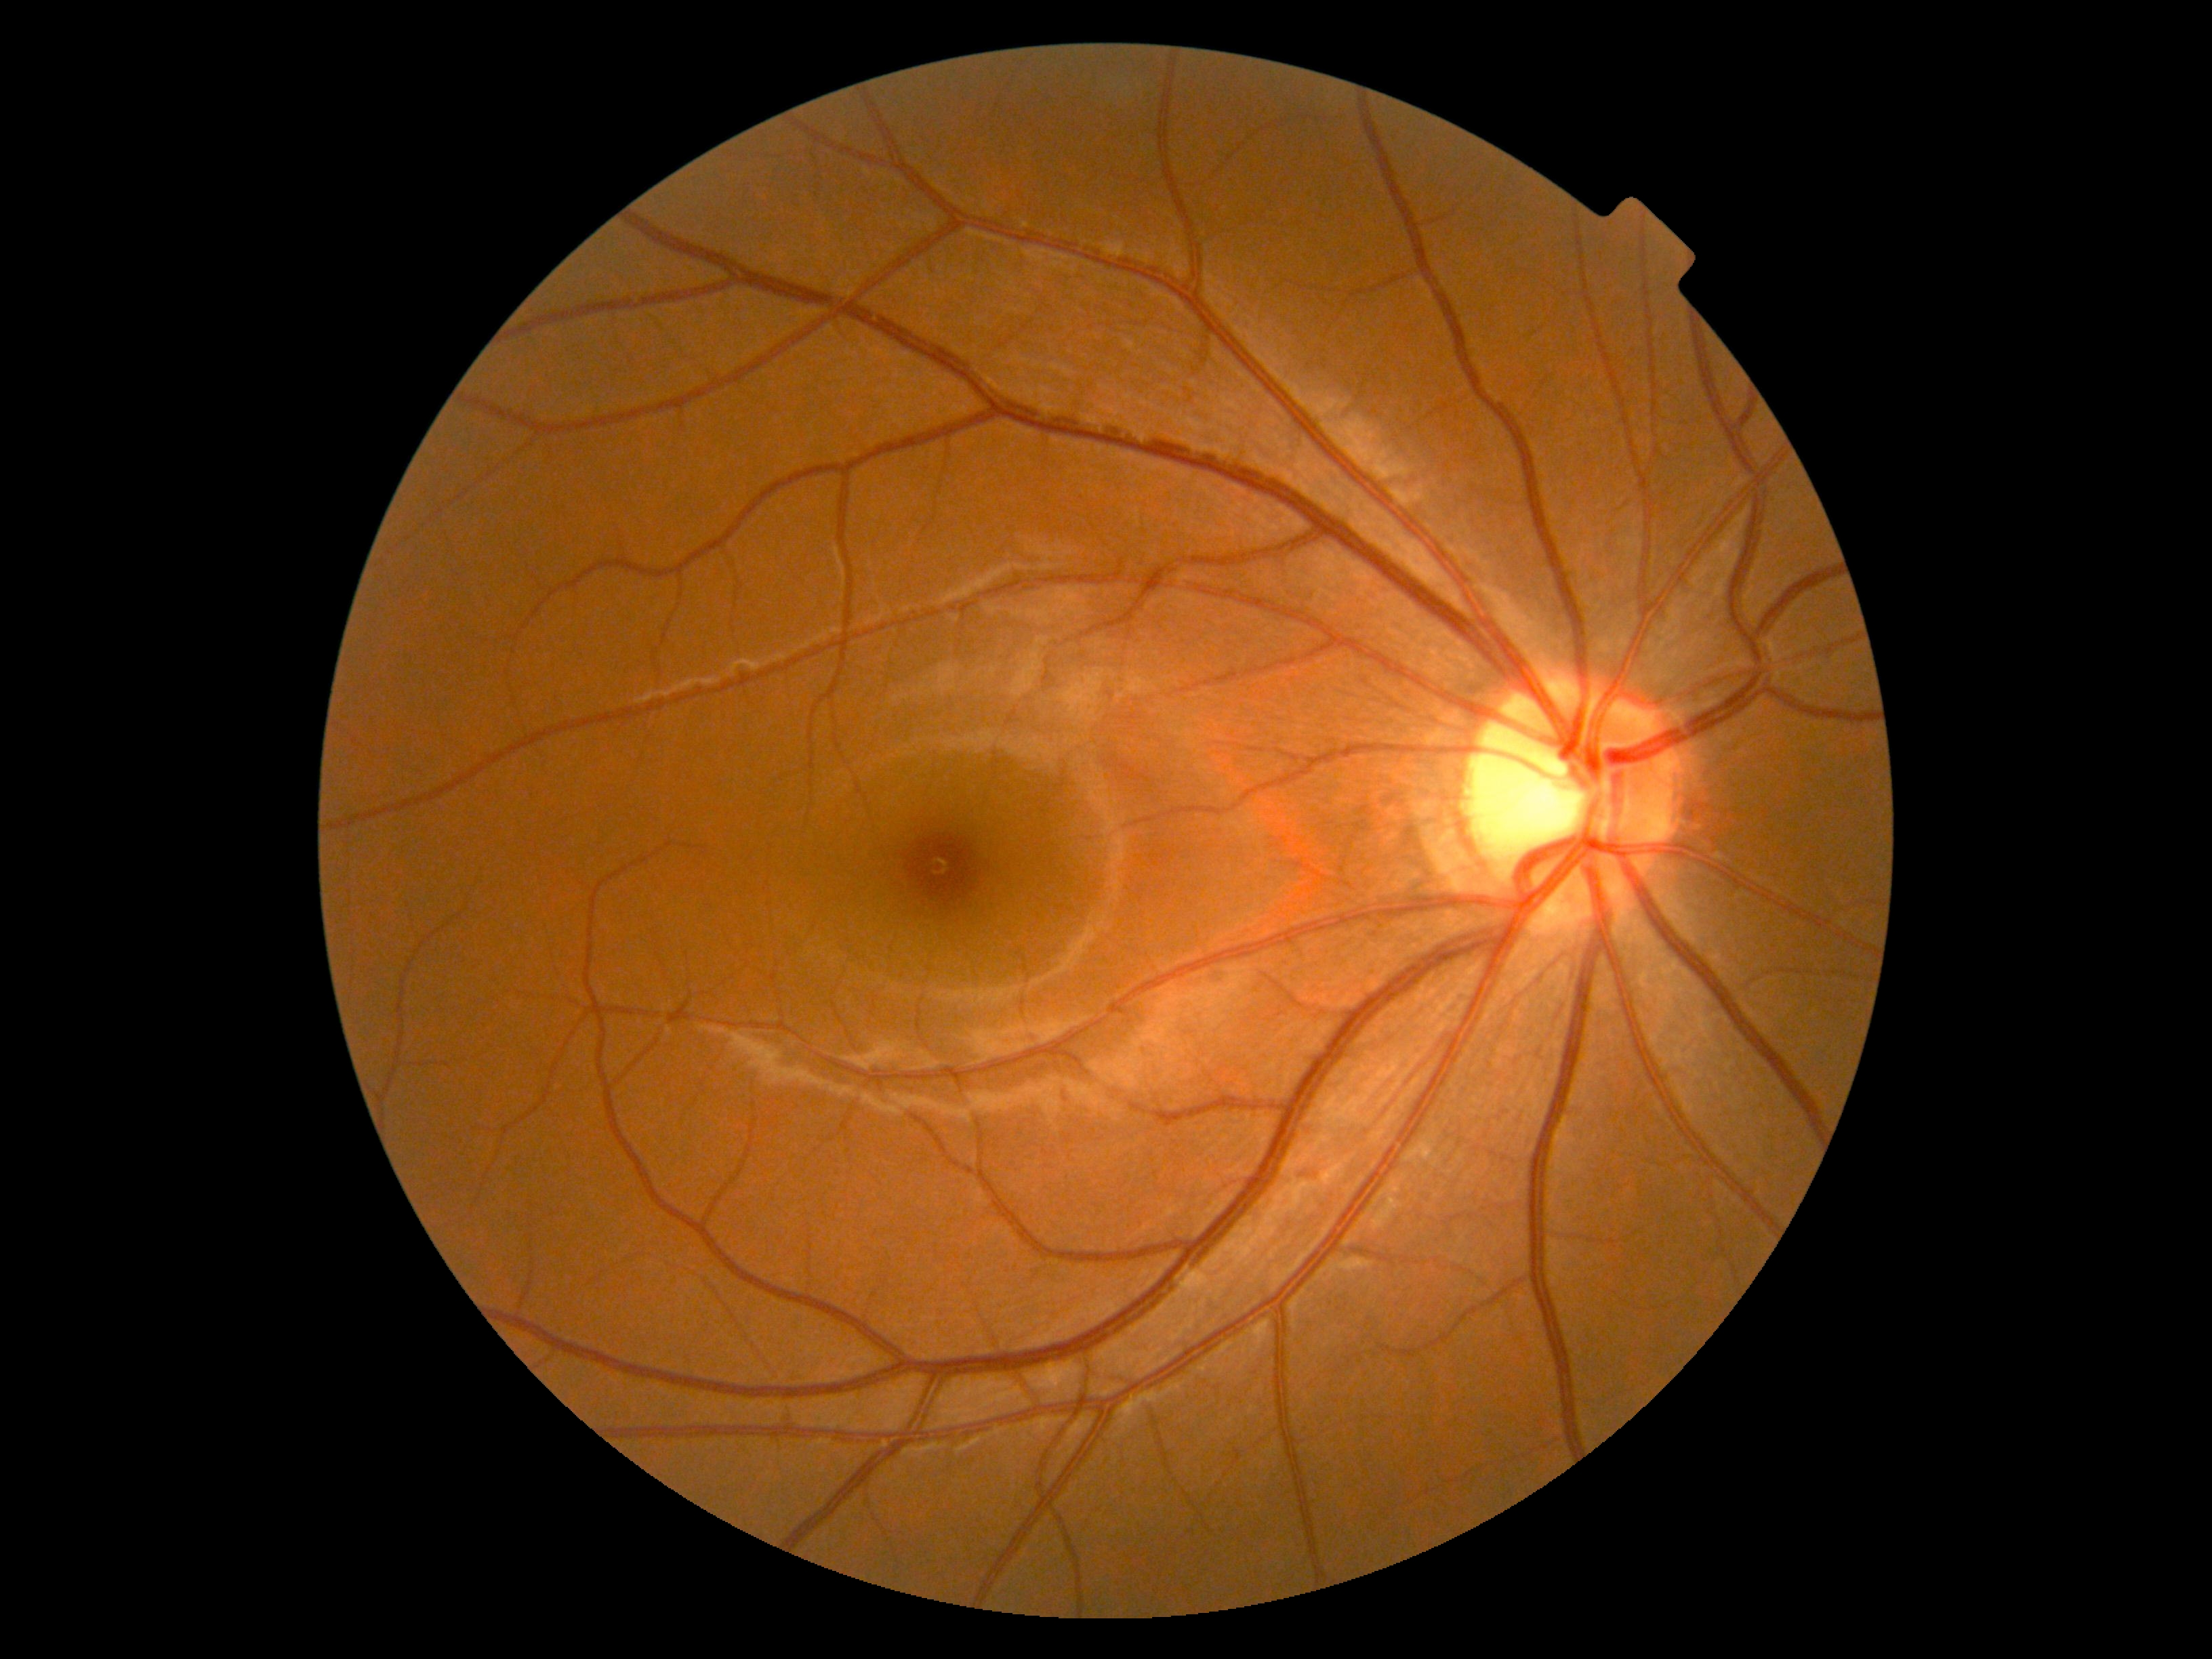
Retinopathy is grade 0 (no apparent retinopathy).